45° FOV:
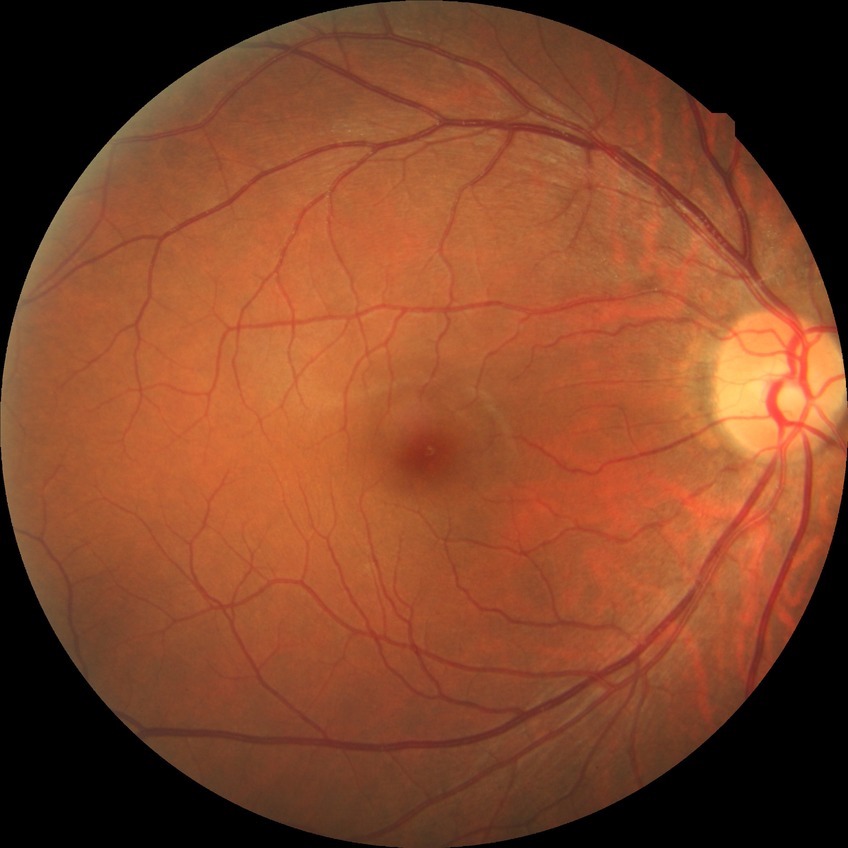 • modified Davis classification: no diabetic retinopathy